1924x1556, ultra-widefield fundus photograph.
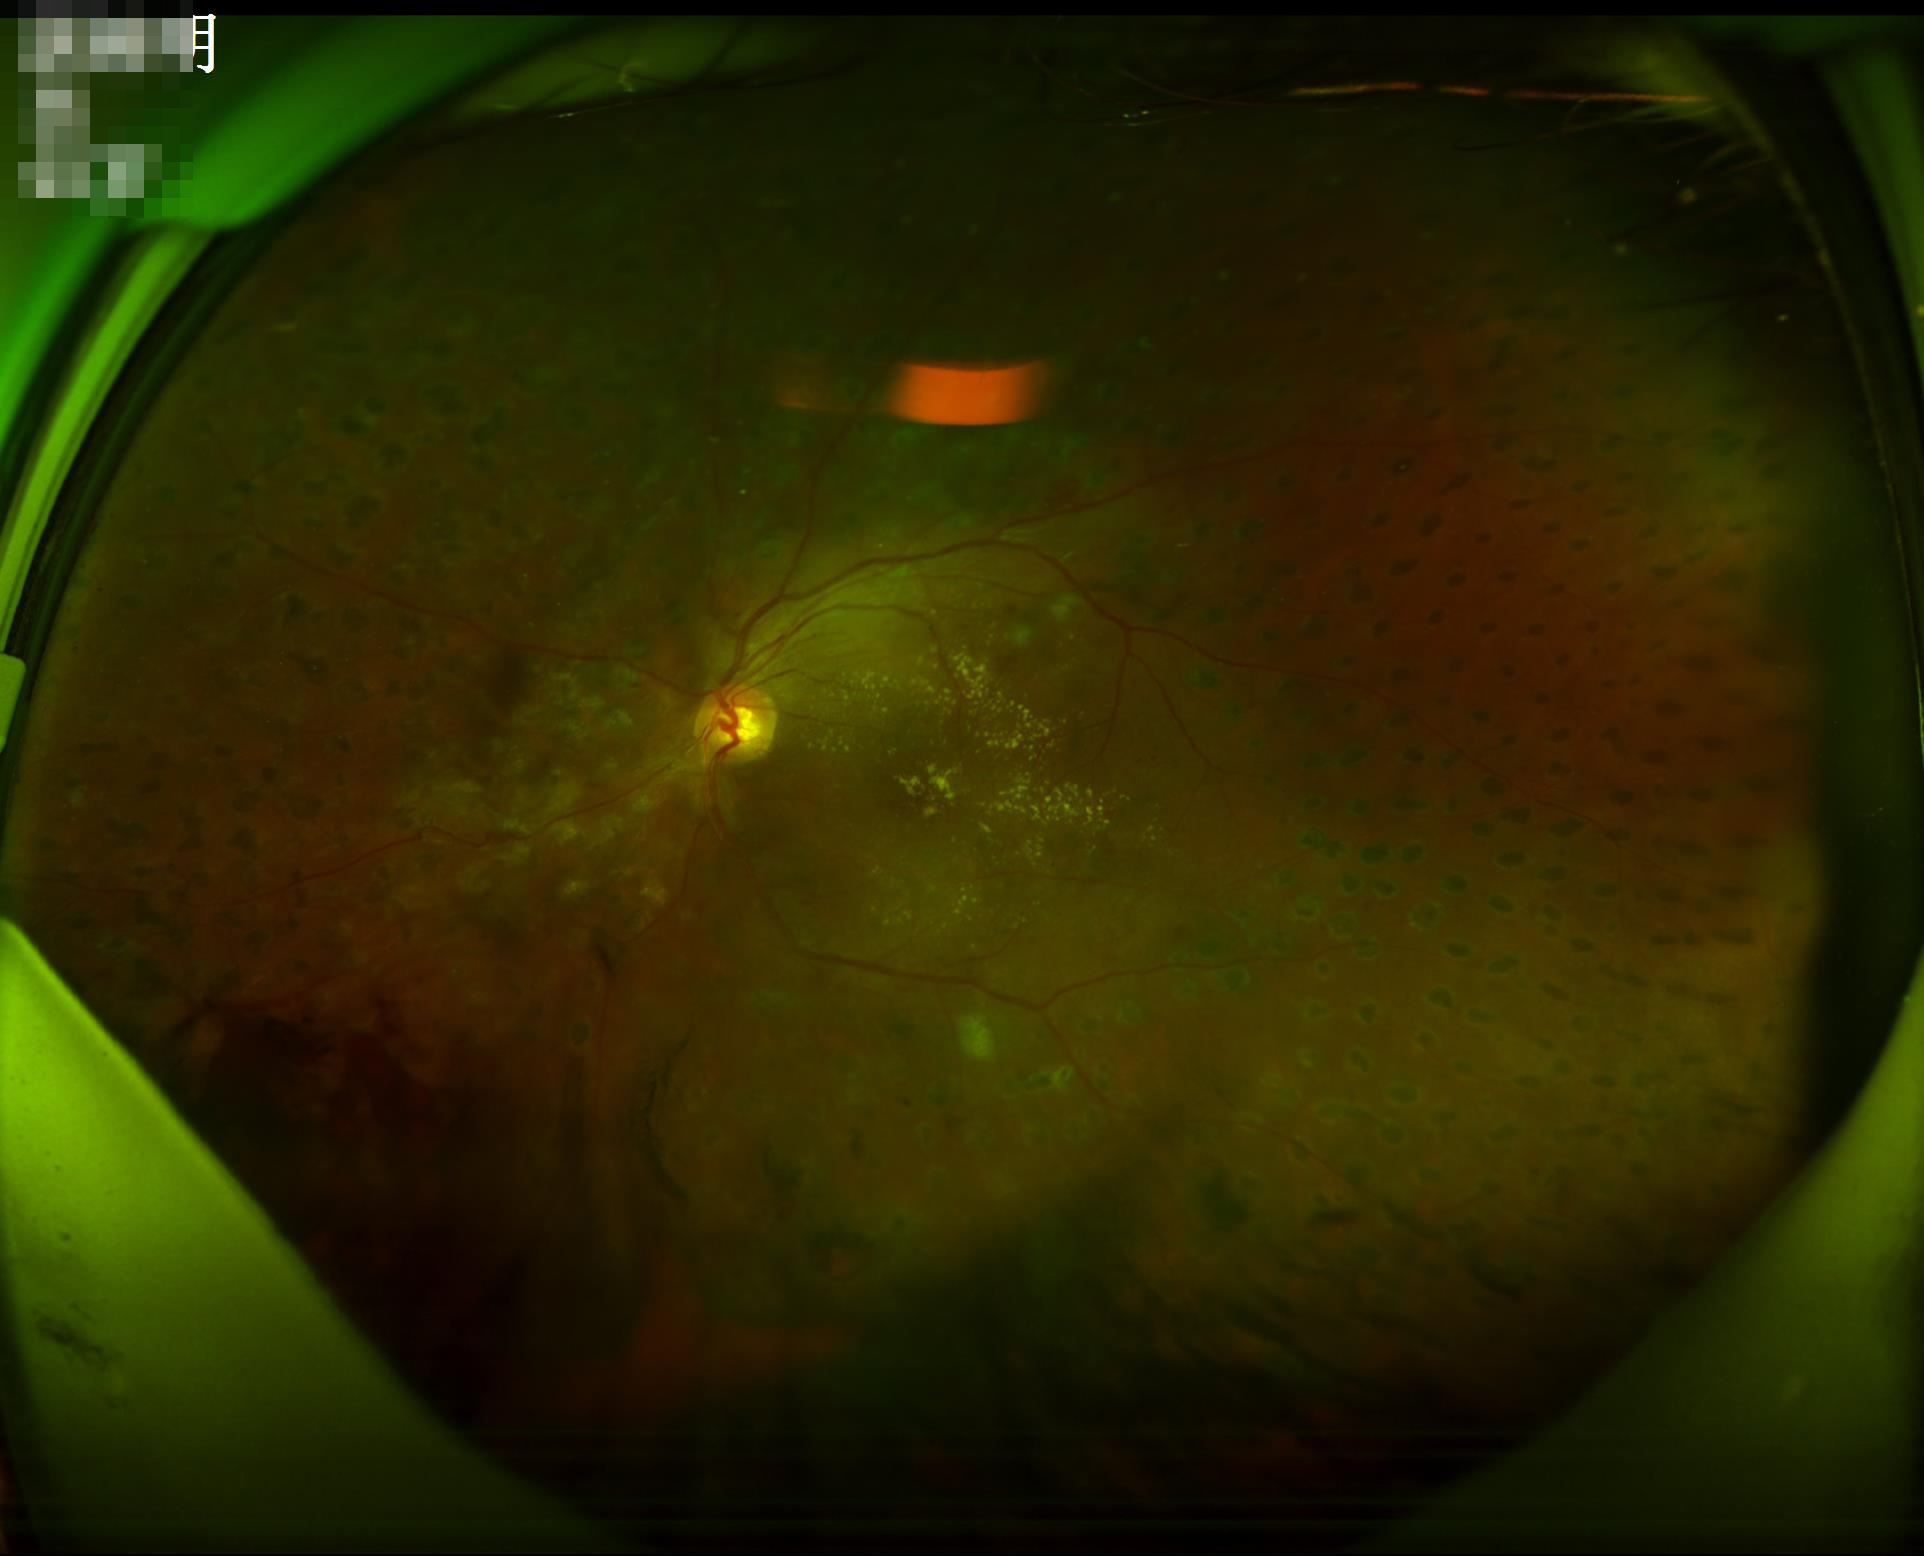
Adequate contrast for distinguishing structures. Overall quality is good and the image is gradable. Illumination and color are suboptimal.